Acquired with a Nidek AFC-330 · centered on the optic disc · non-mydriatic acquisition
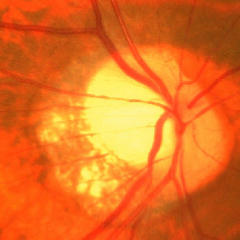
Glaucomatous optic neuropathy is present. Optic disc appearance consistent with advanced-stage glaucoma.